DR severity per modified Davis staging. NIDEK AFC-230 — 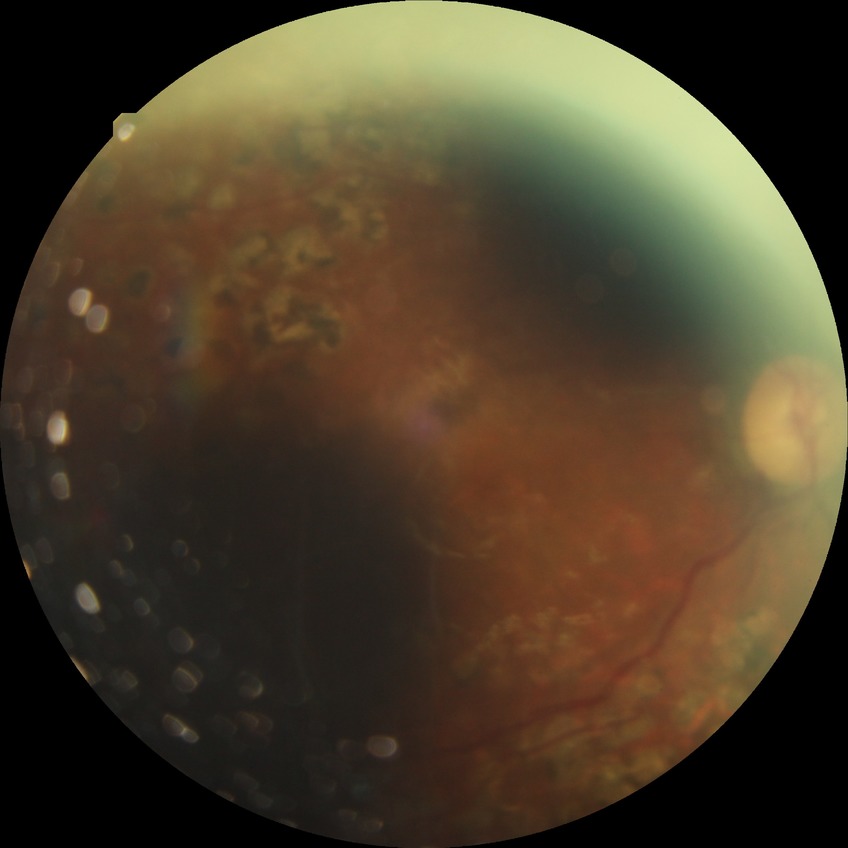
Diabetic retinopathy (DR): PDR (proliferative diabetic retinopathy).